1659x2212. CFP
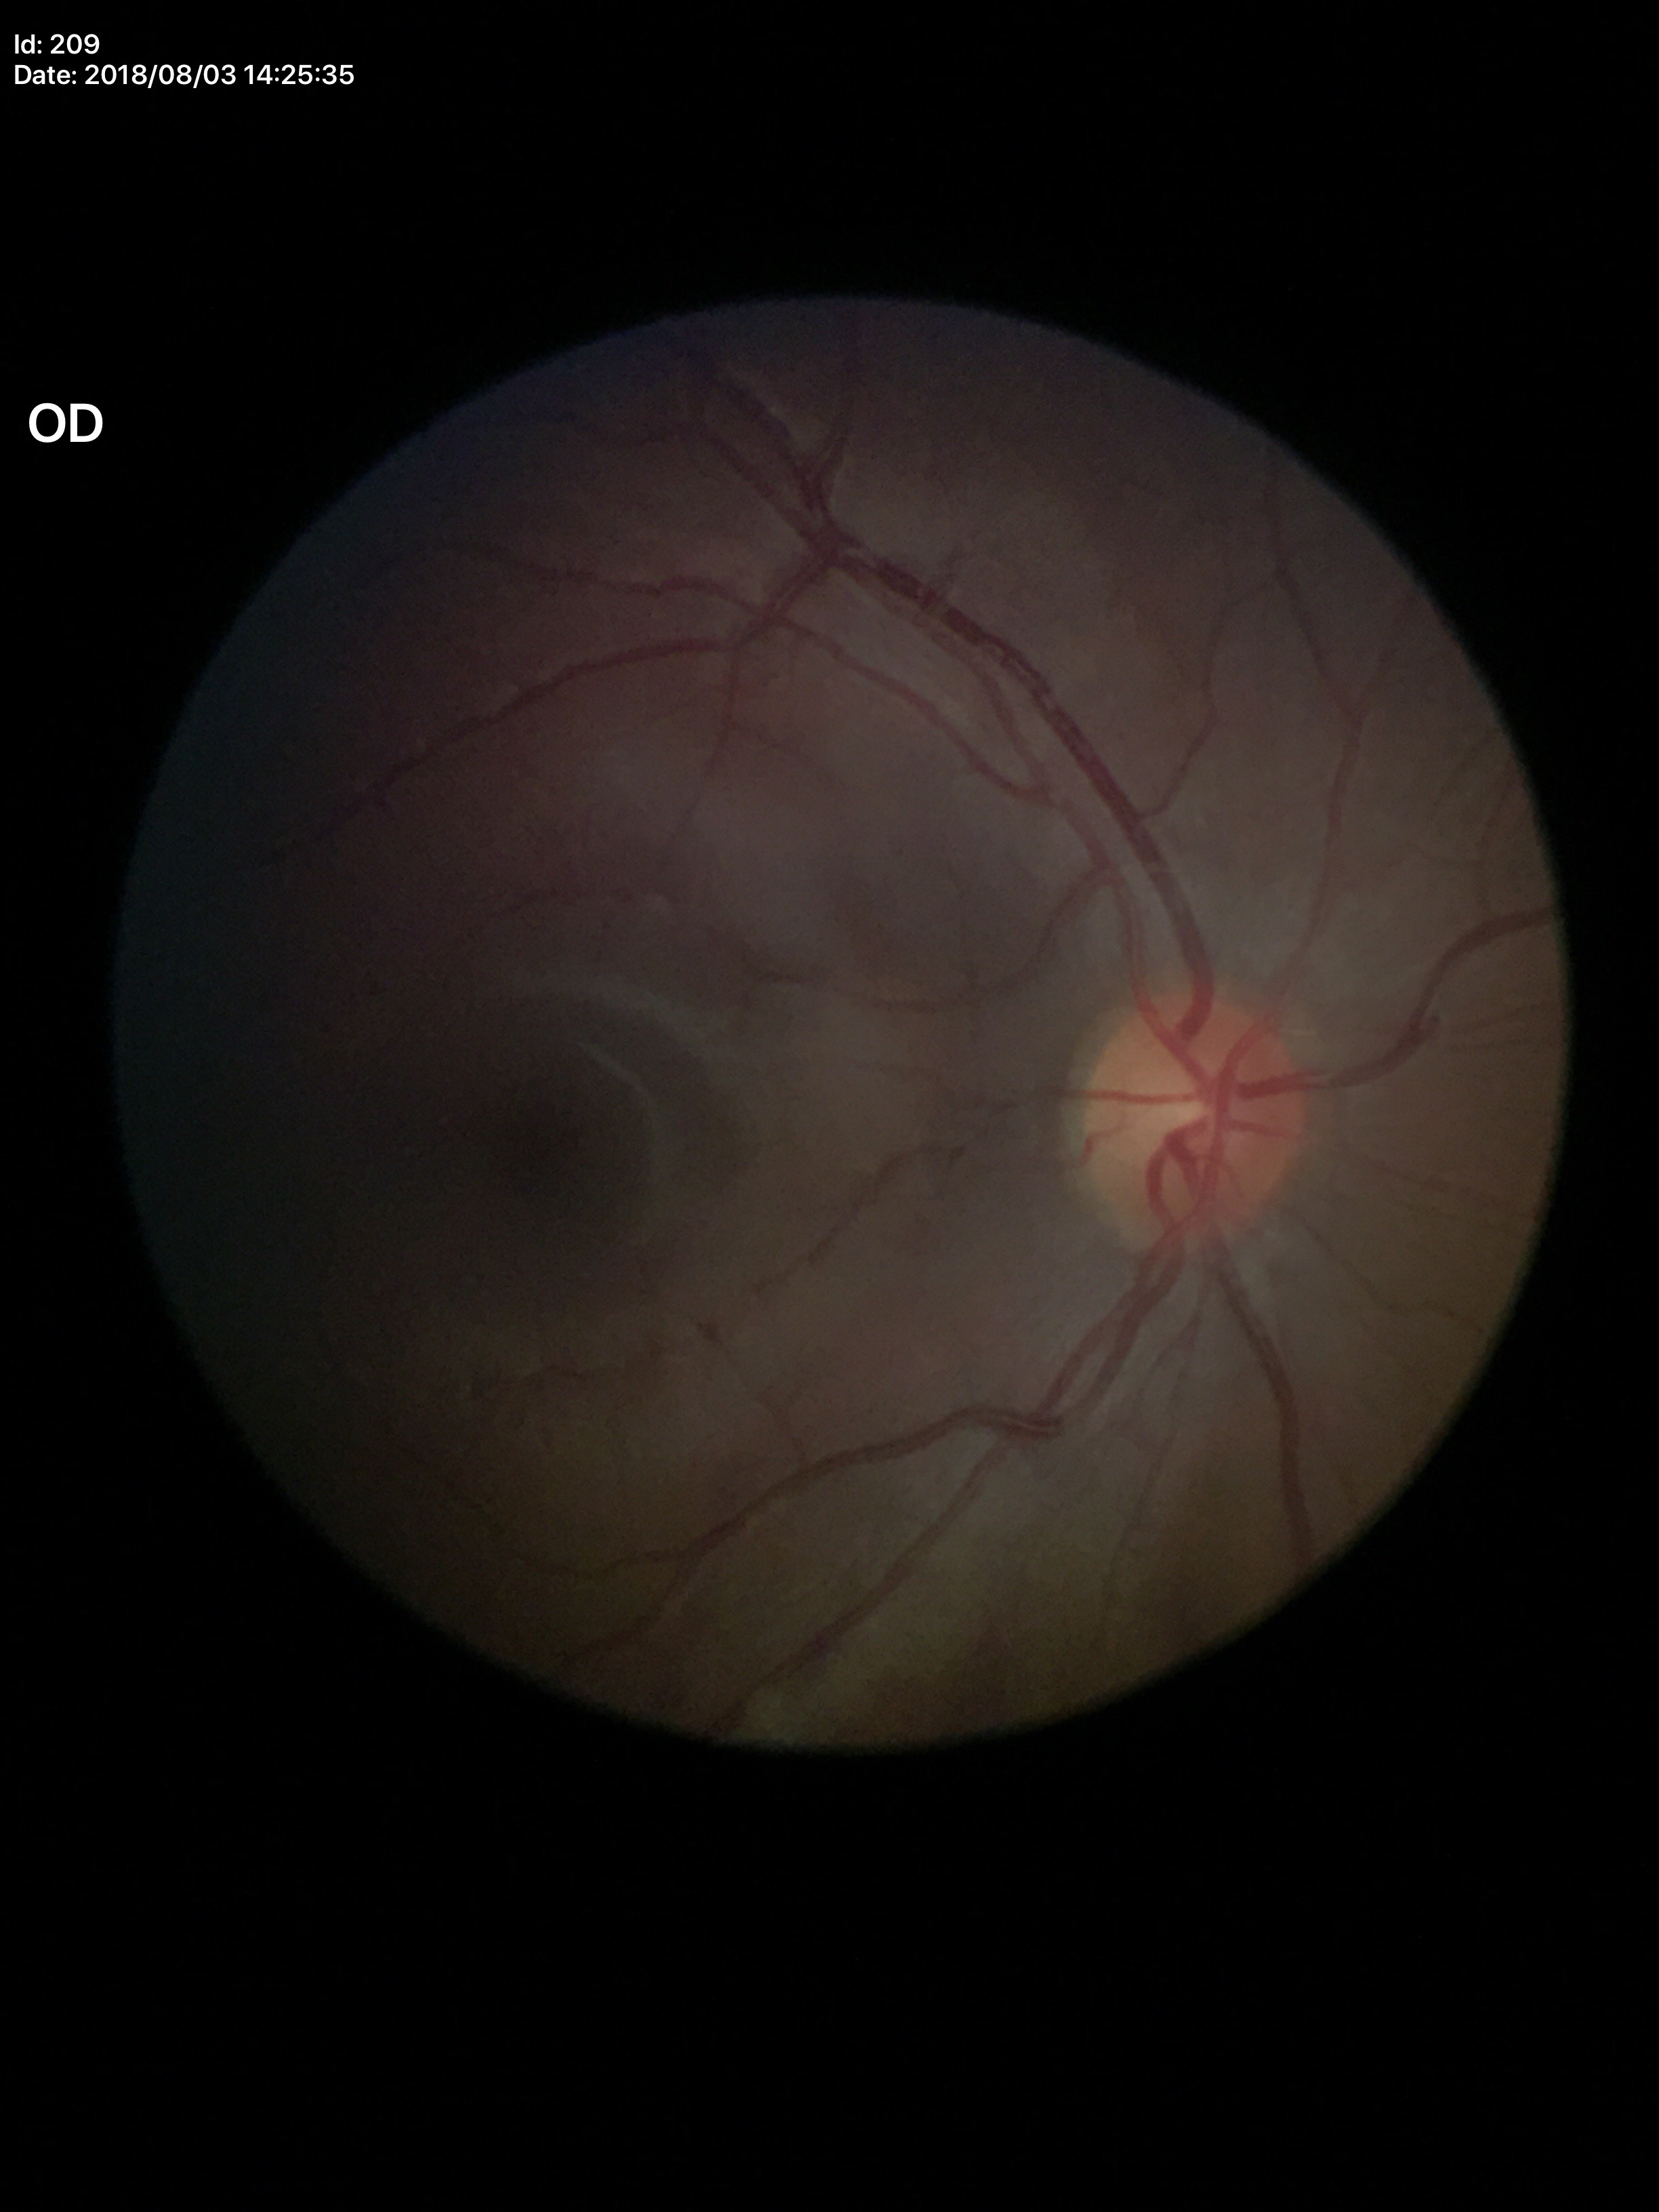 Glaucoma evaluation = no suspicious findings | horizontal cup-to-disc ratio = 0.44 | vertical CDR = 0.45.